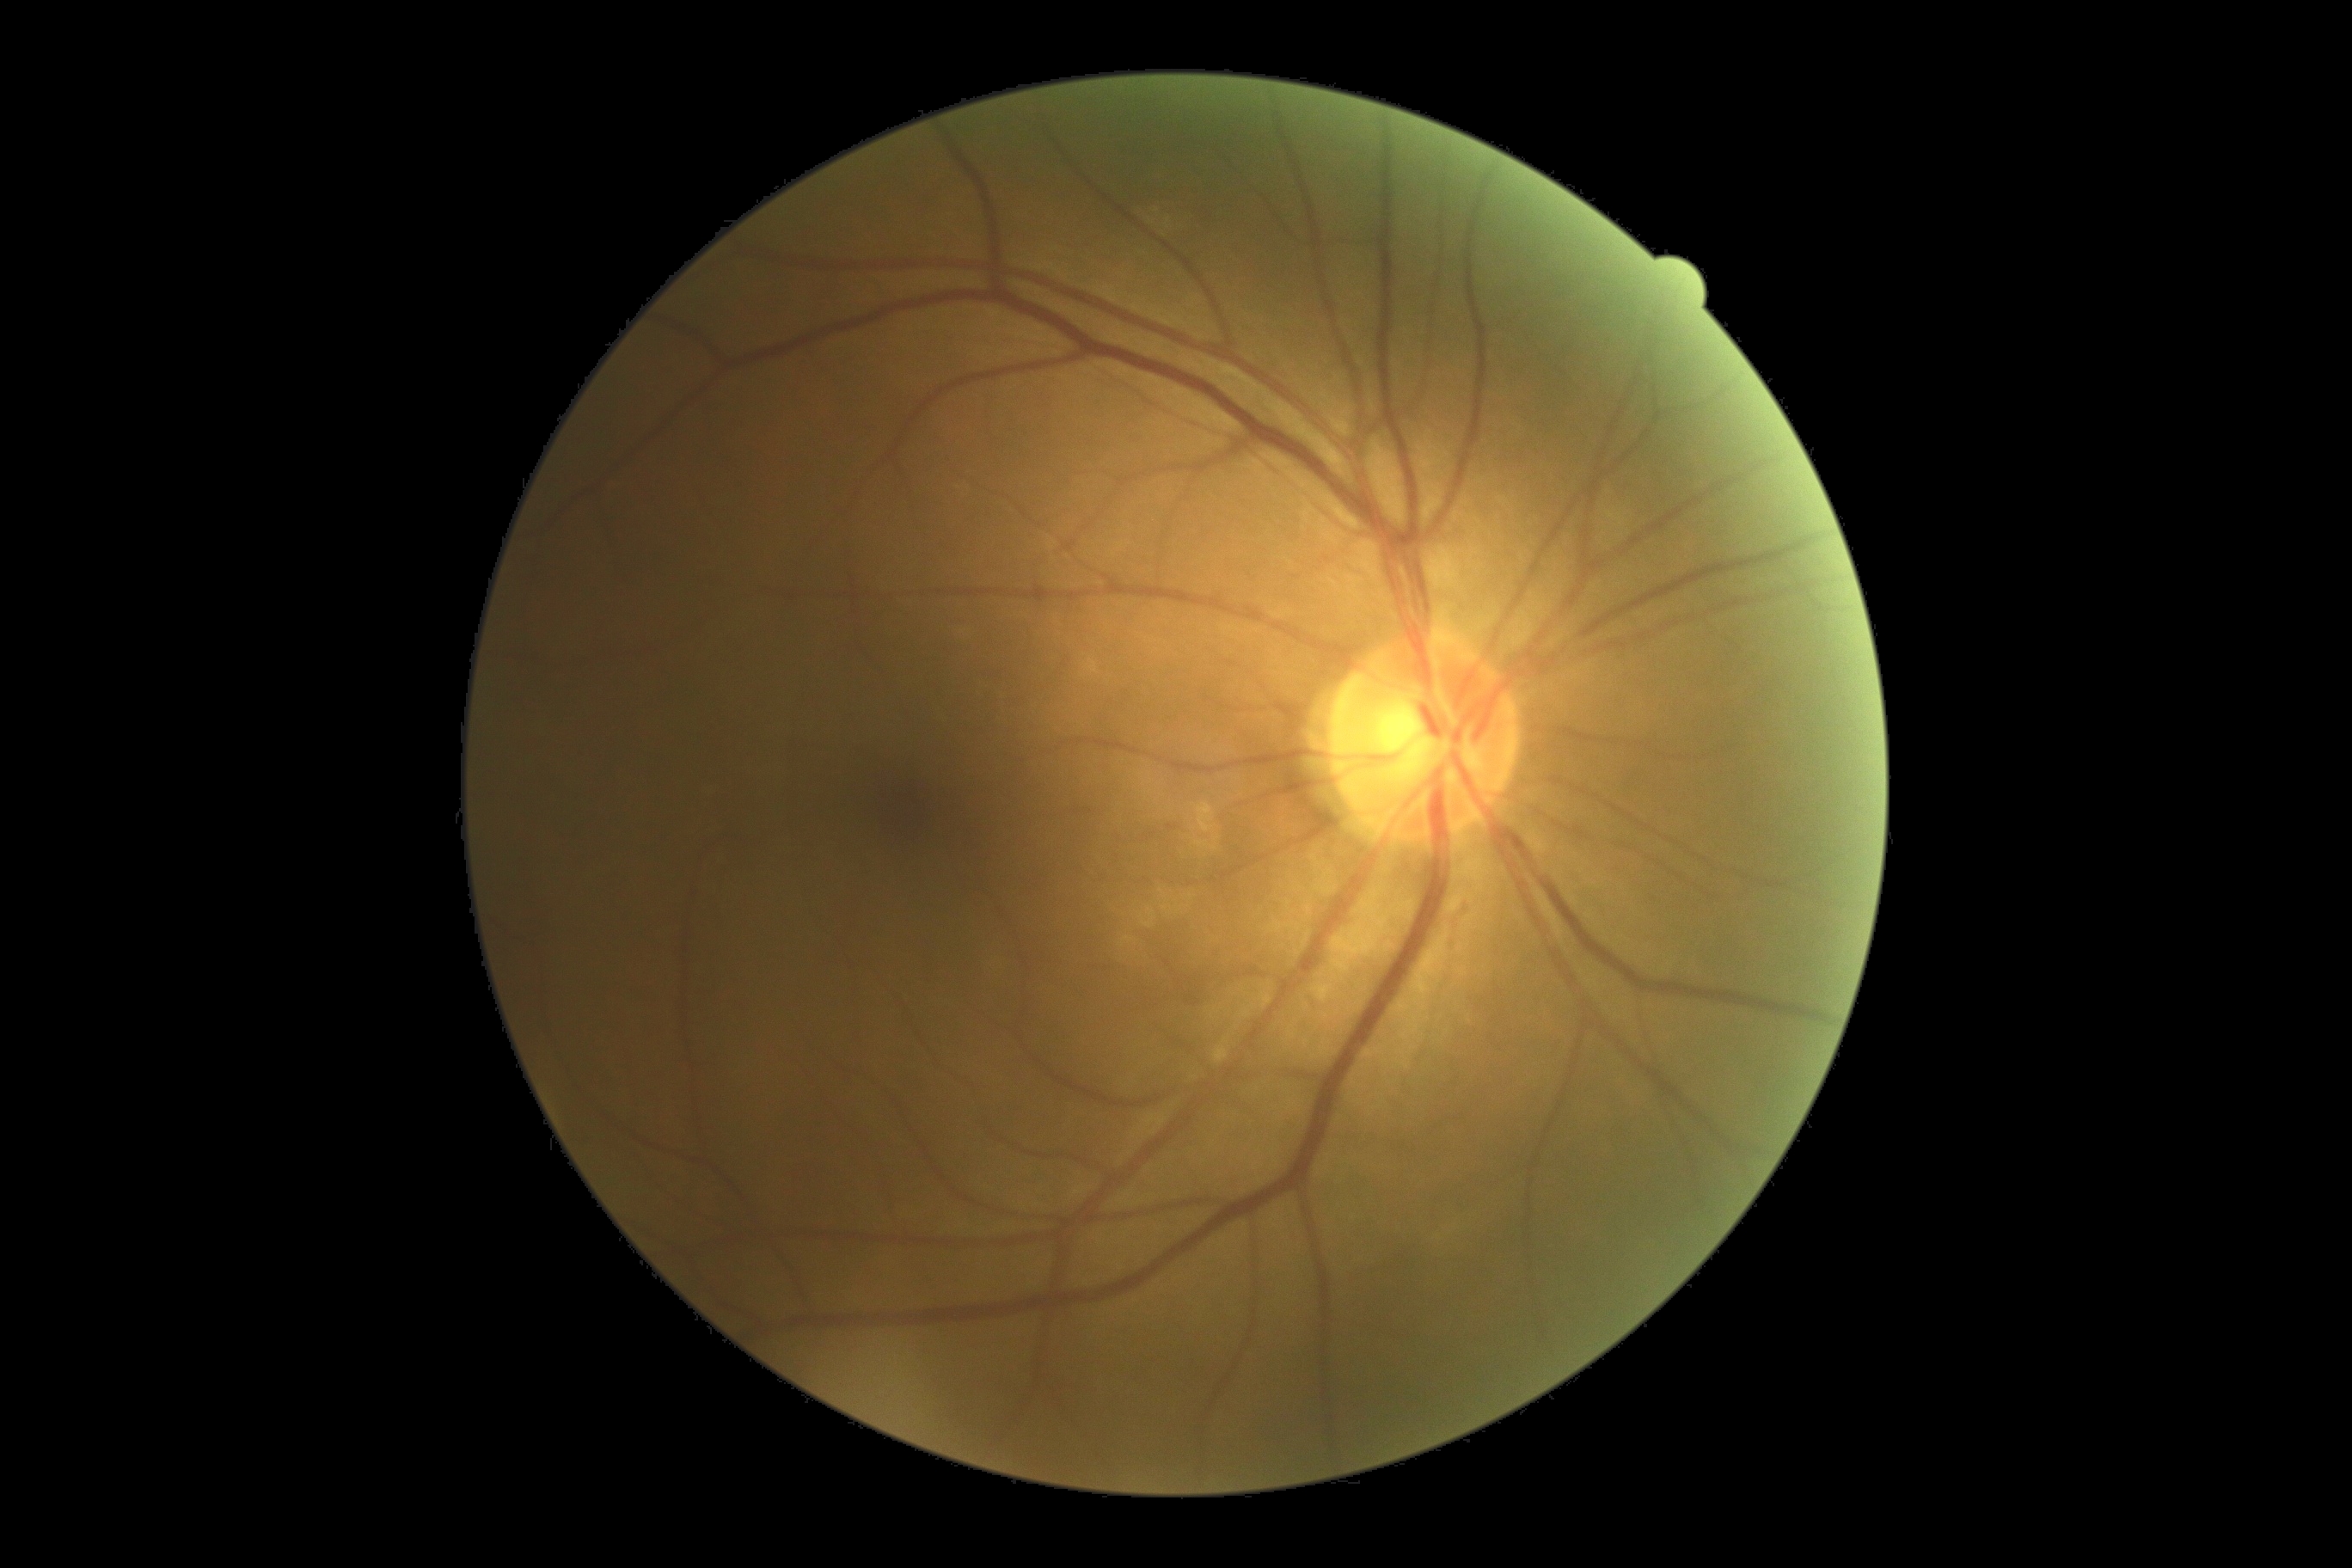 Diabetic retinopathy (DR) is grade 0 — no visible signs of diabetic retinopathy.